Wide-field fundus image from infant ROP screening; 1240x1240px.
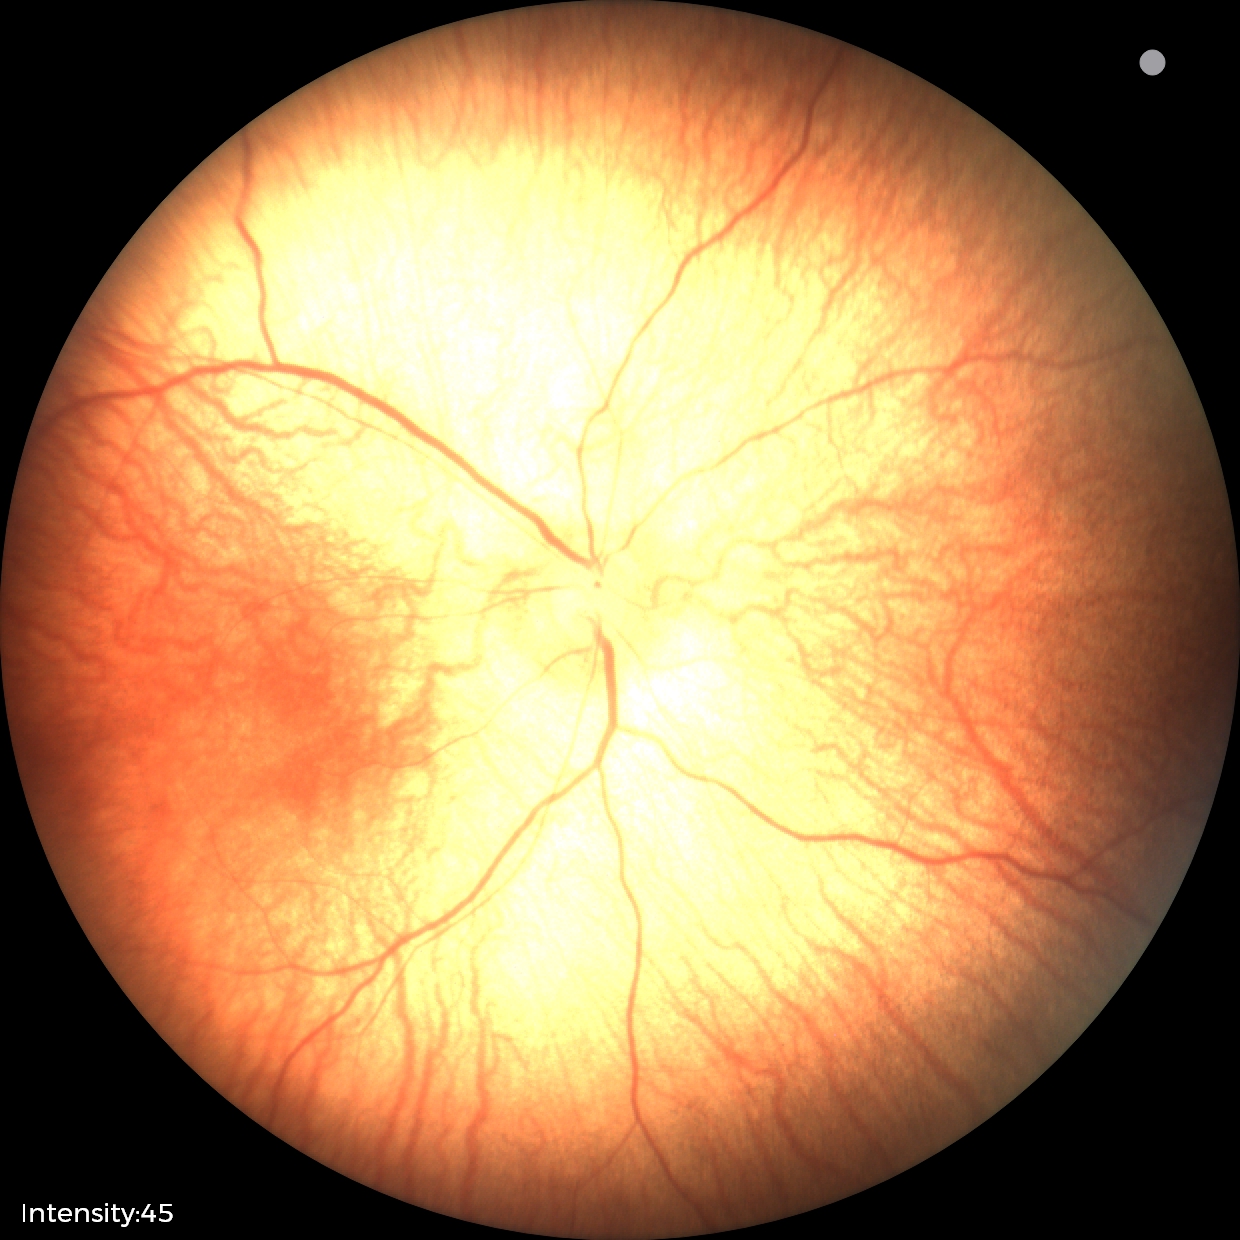
Screening examination with no abnormal retinal findings.